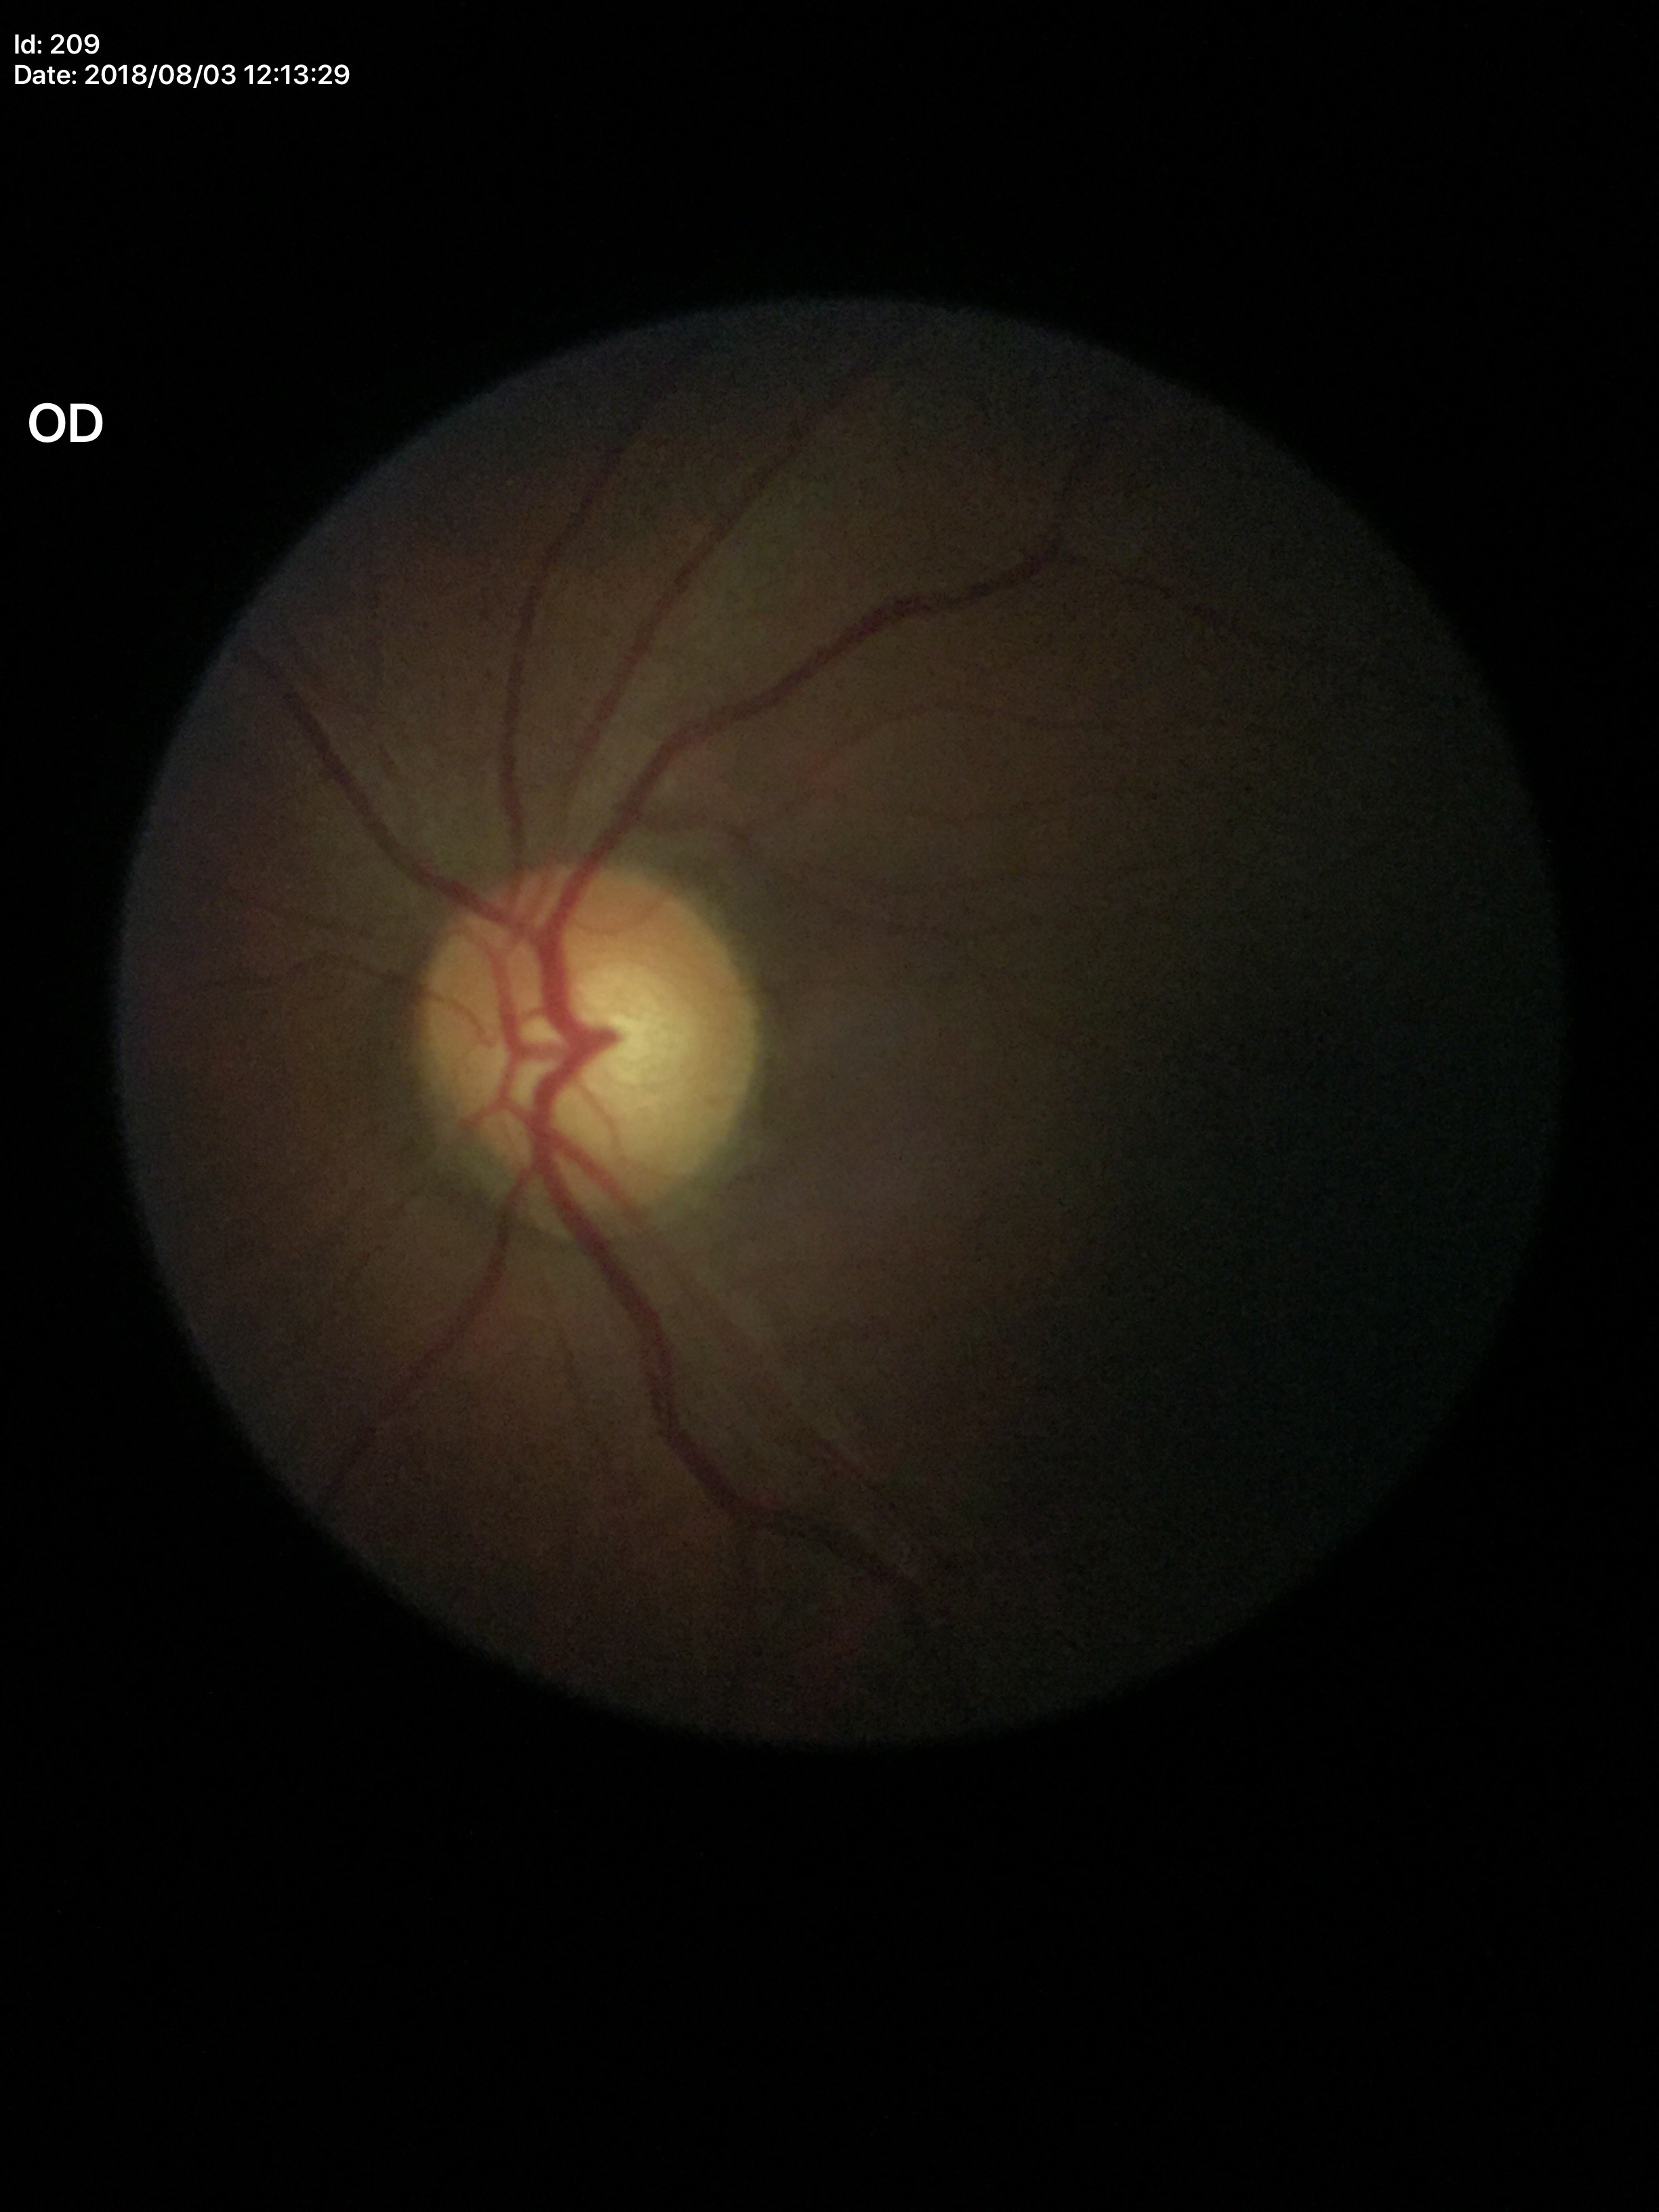

Vertical cup-disc ratio is 0.56. Horizontal CDR of 0.60. No glaucomatous optic neuropathy (2/5 graders called glaucoma suspect).